Color fundus photograph: 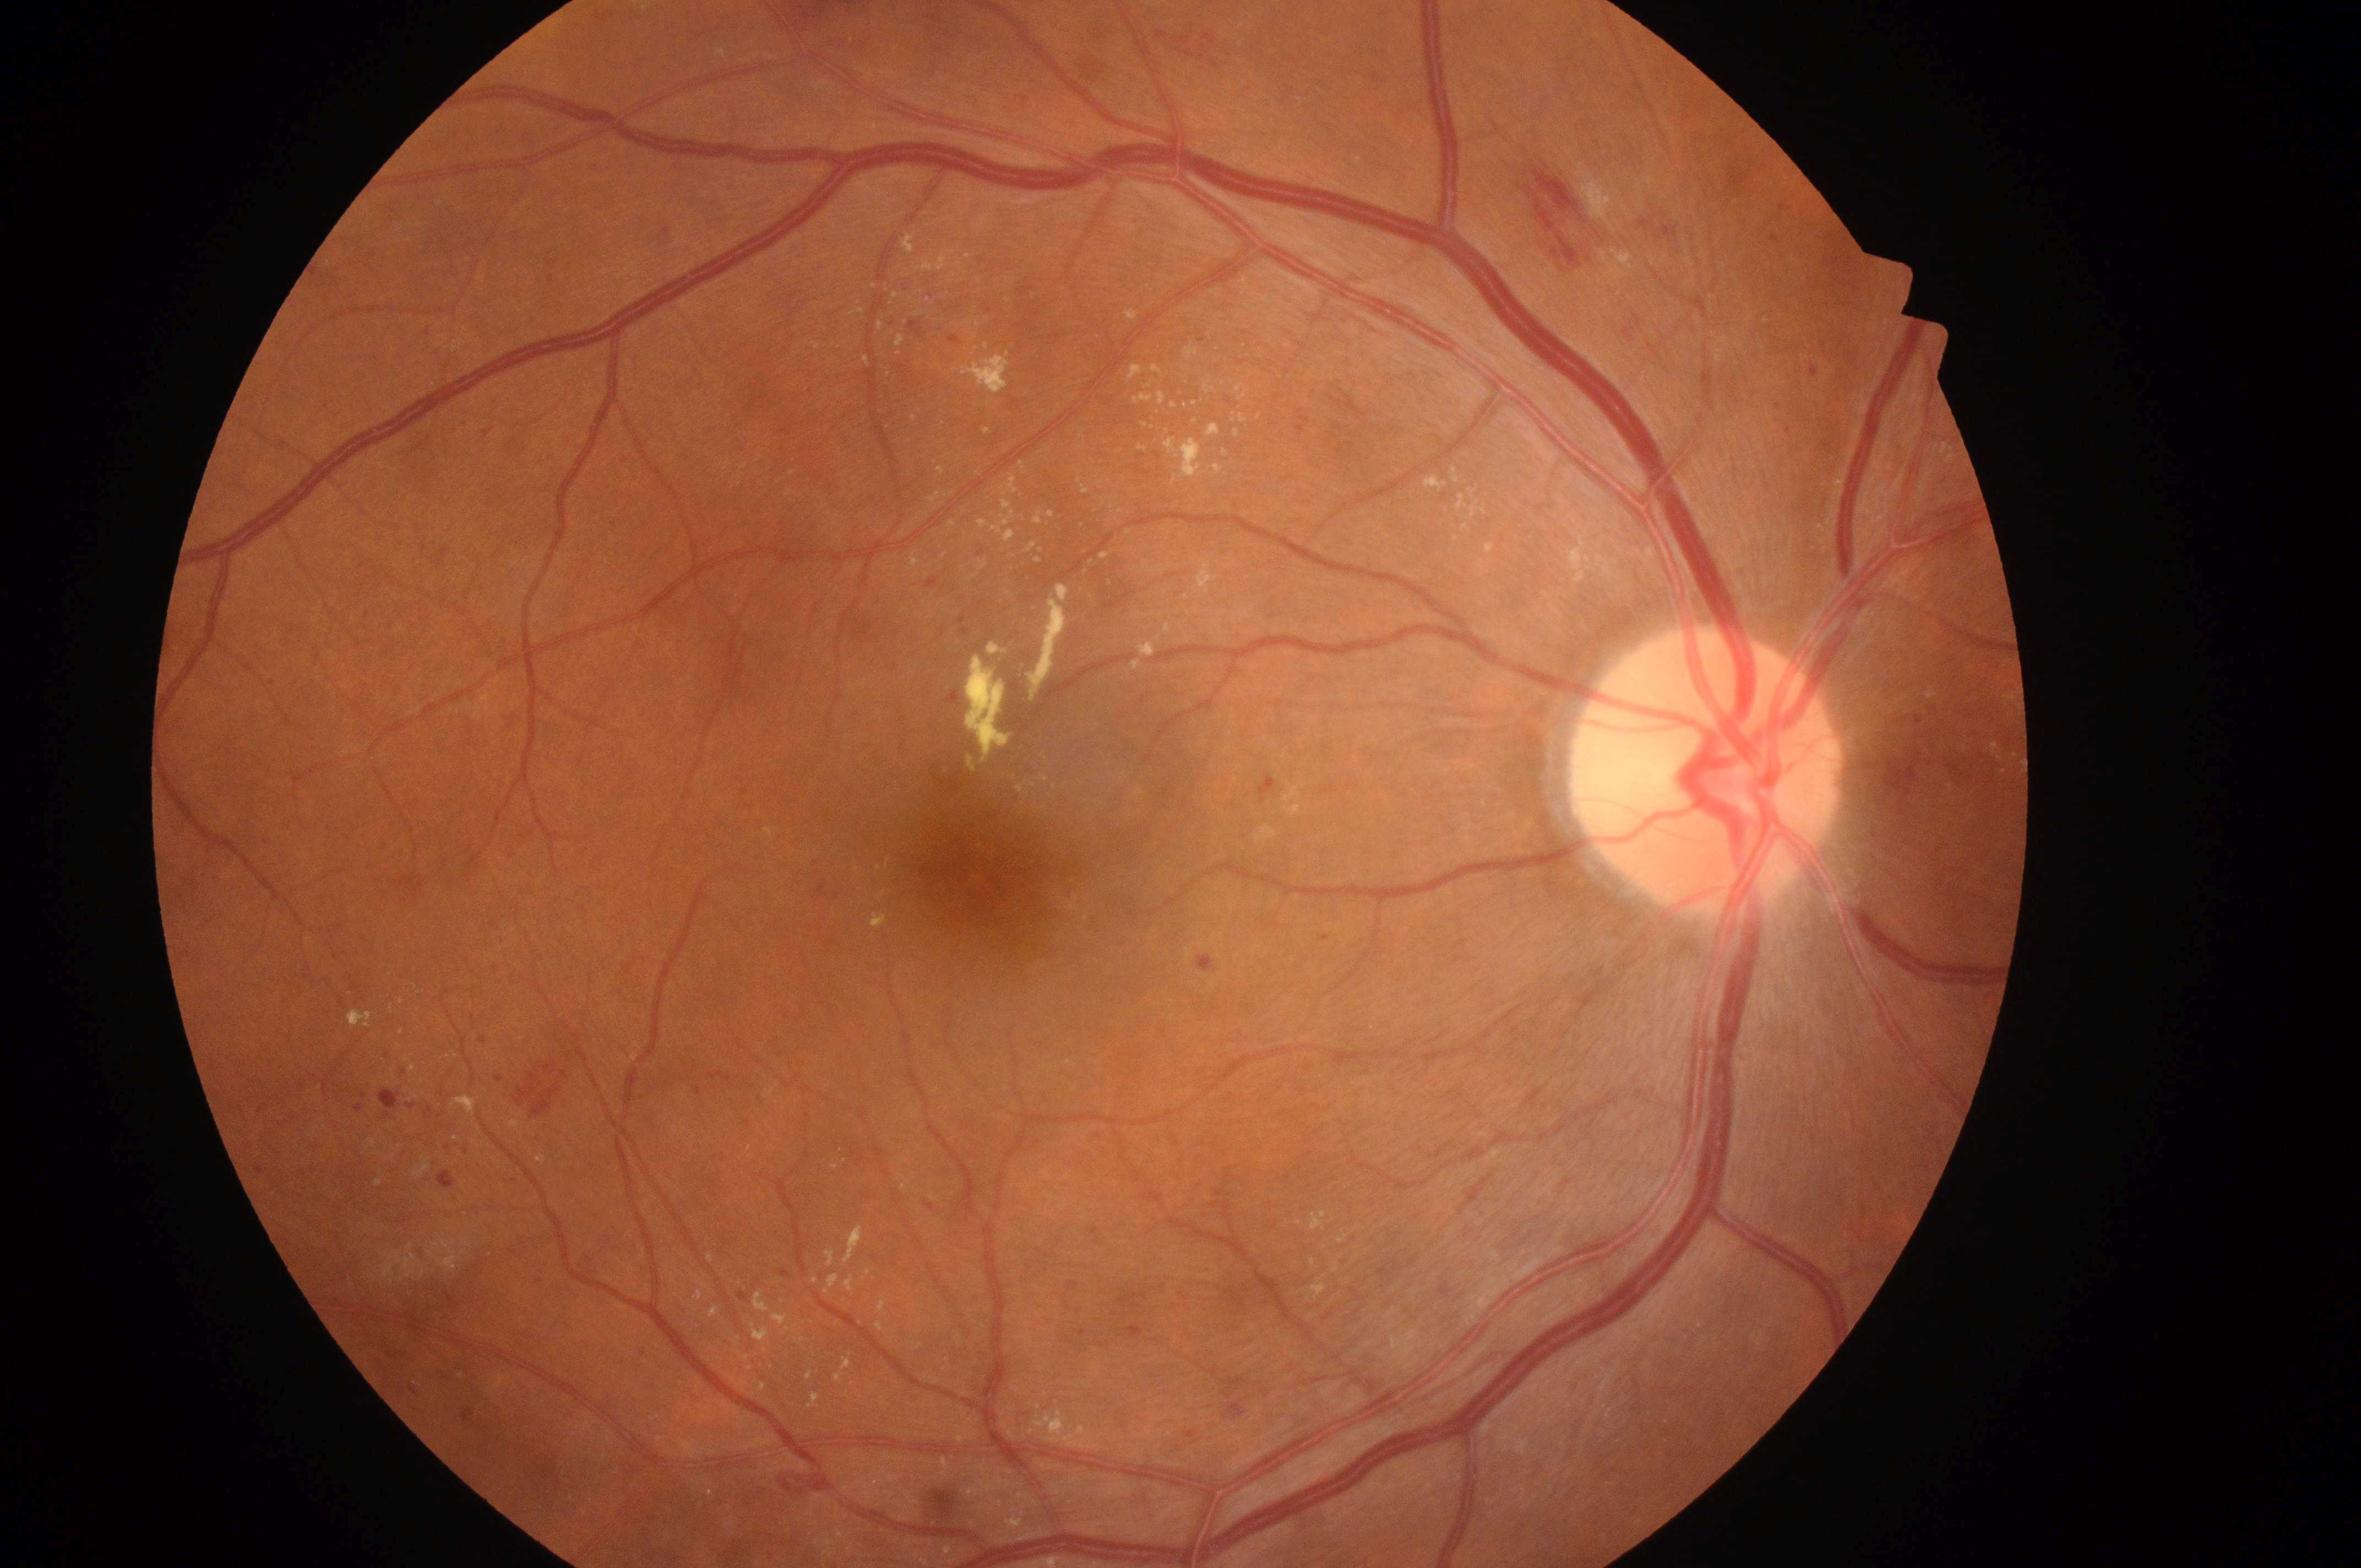

Diabetic retinopathy (DR) is severe non-proliferative diabetic retinopathy (grade 3).
Diabetic macular edema (DME): grade 2 (high risk).
Eye: the right eye.
Macula center: x=986, y=878.
Optic nerve head: x=1706, y=783.